Optic disc-centered crop from a color fundus photograph, acquired with a Topcon TRC.
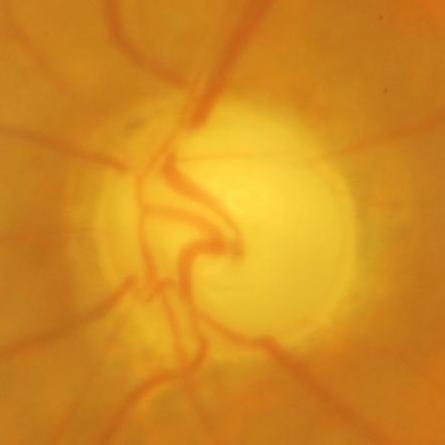
Impression = evidence of glaucoma.